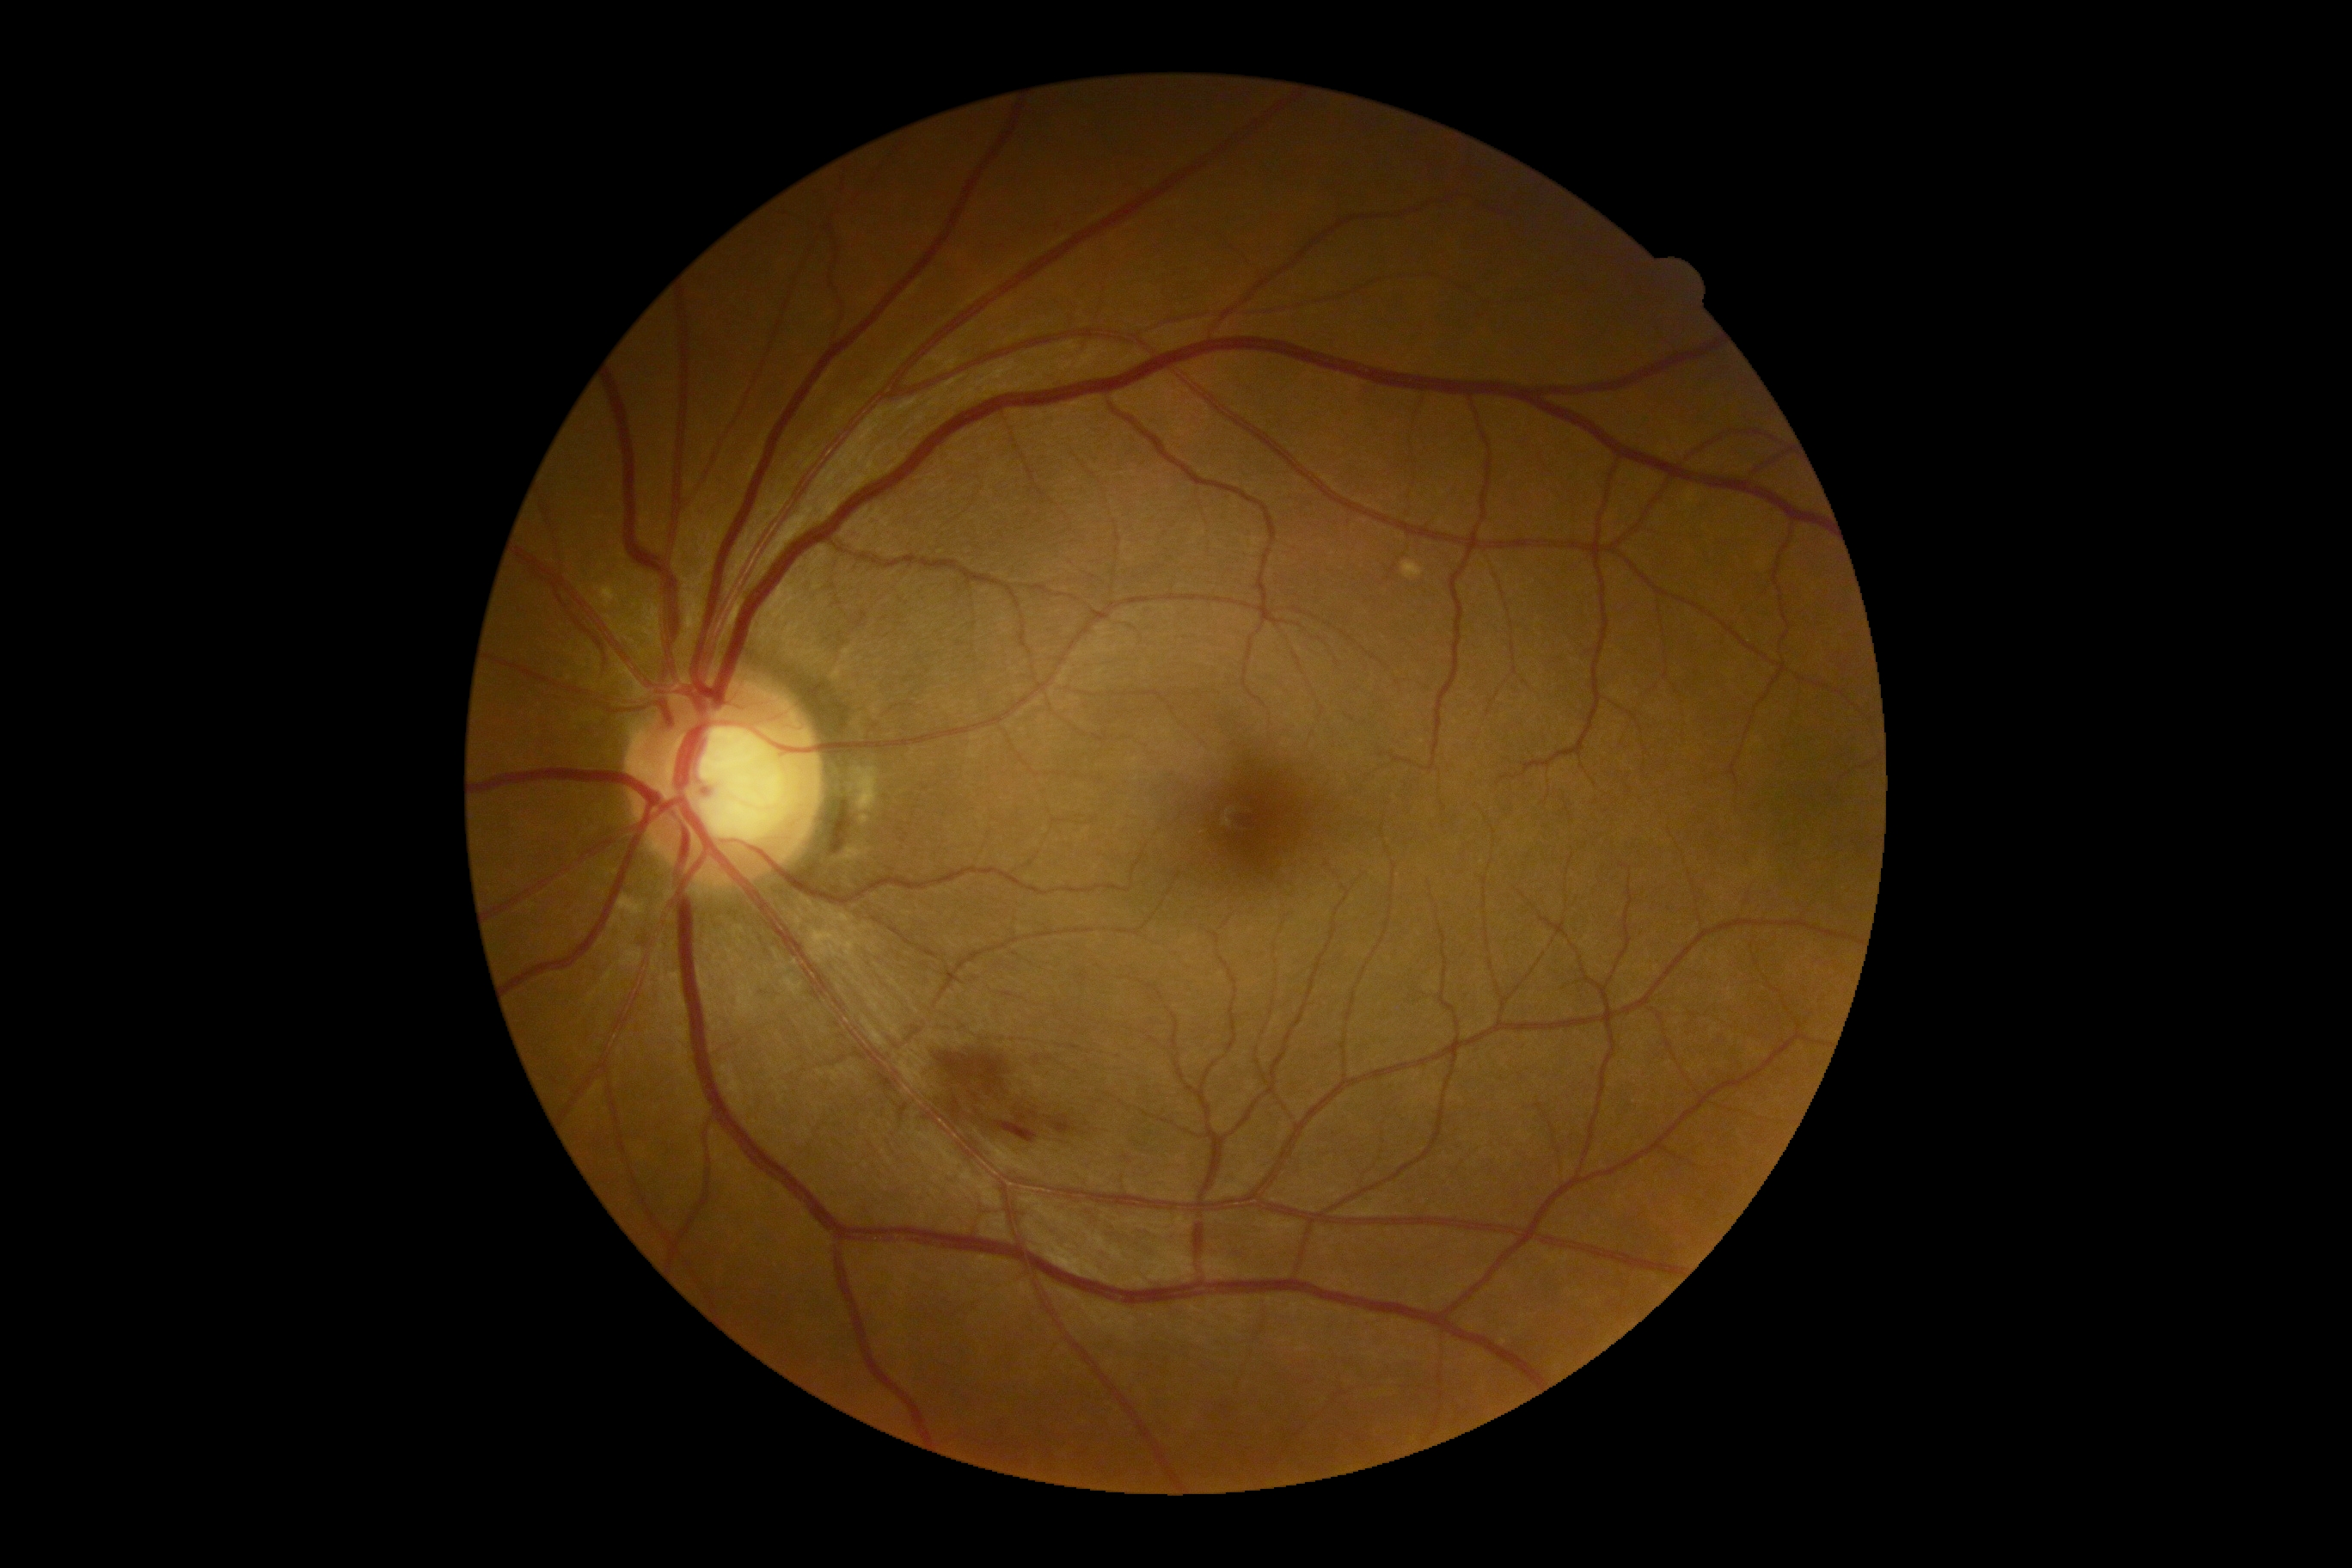

DR stage: 2/4.
DR class: non-proliferative diabetic retinopathy.